Wide-field contact fundus photograph of an infant
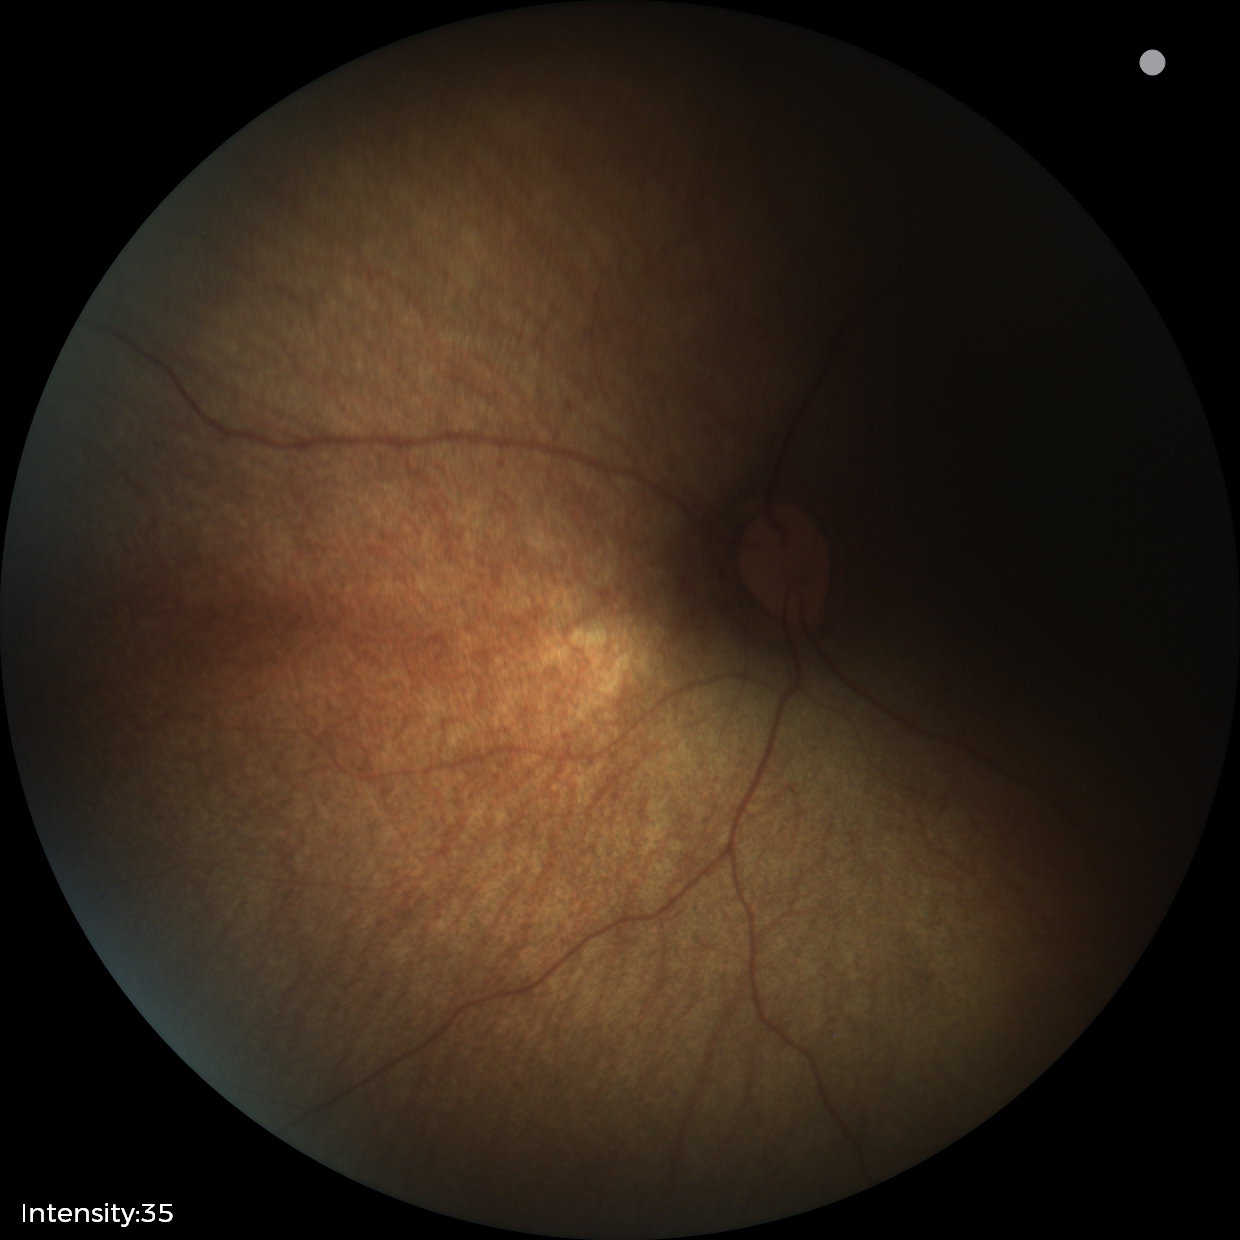
Finding = no pathology identified.